848x848px · fundus photo — 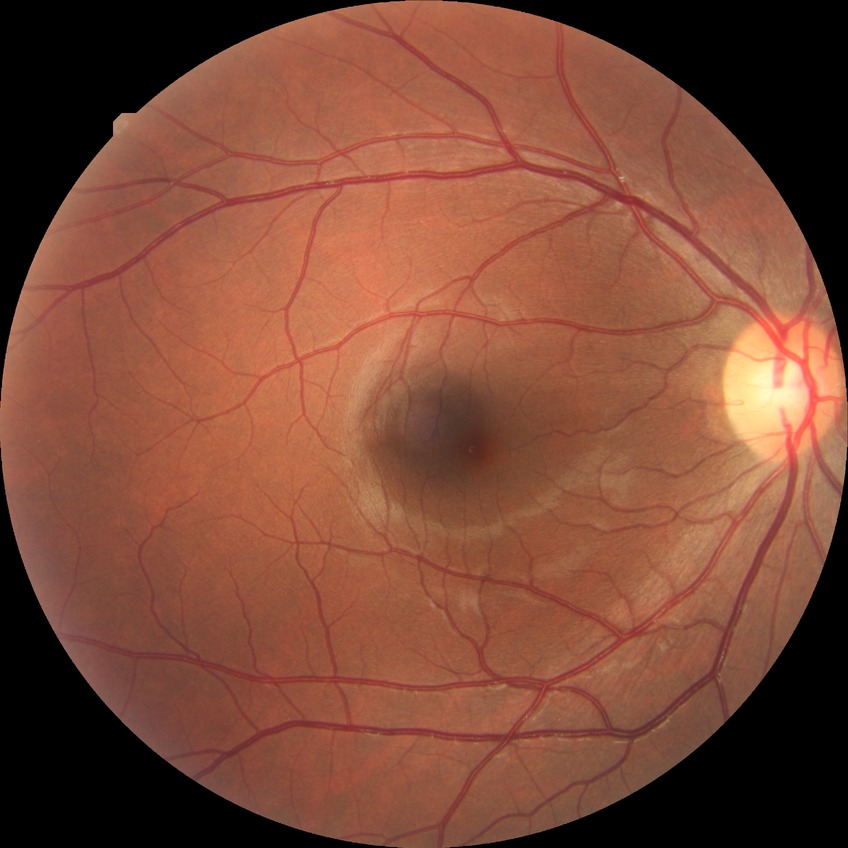
Davis DR grade: NDR.